240x240. Centered on the optic disc. Non-mydriatic — 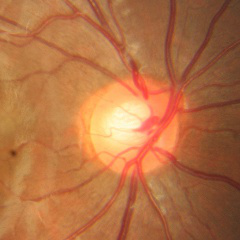 Impression: no glaucomatous changes.